412 x 310 pixels:
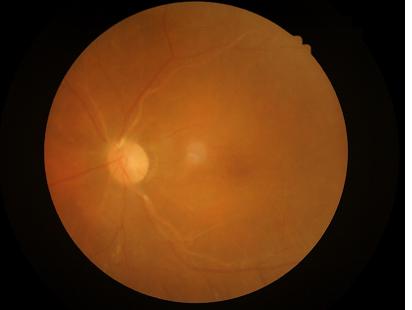

Quality assessment:
- clarity: reduced
- contrast: low
- illumination: good
- overall: suboptimal